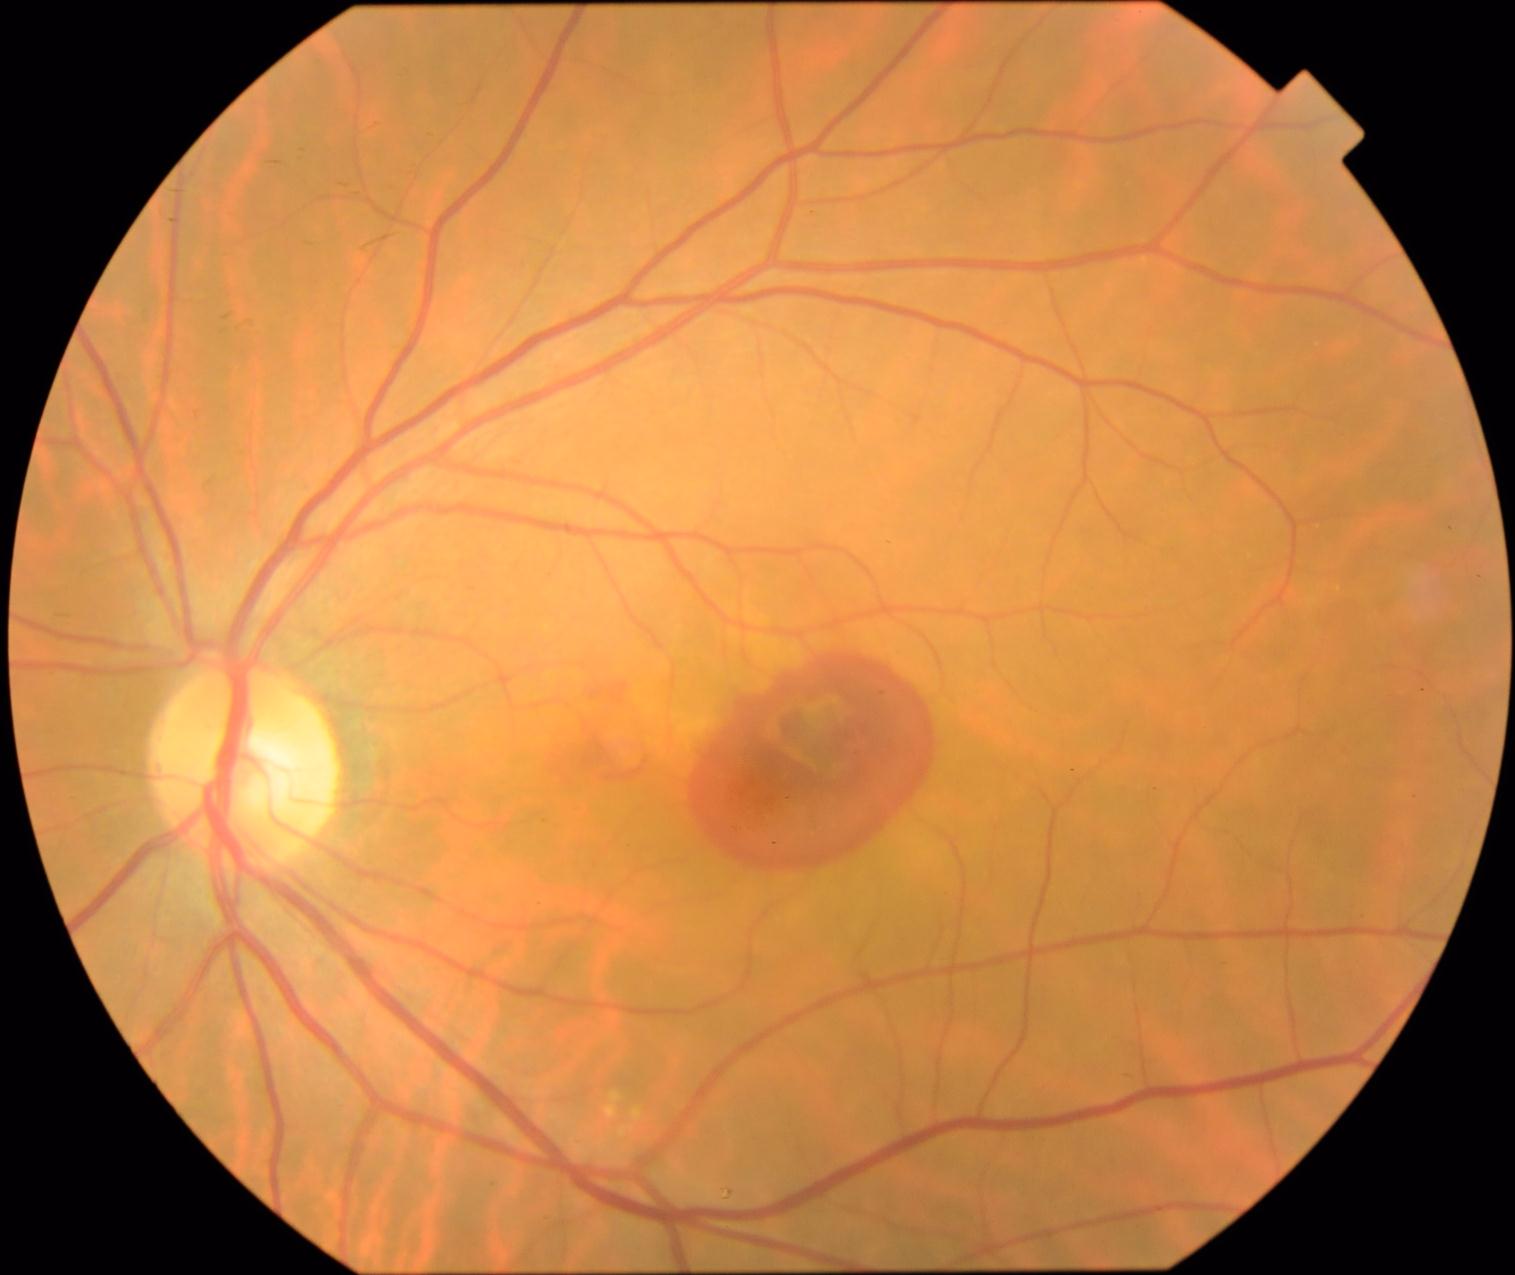
DR severity: grade 4 (PDR).